Captured with the Phoenix ICON (100° field of view); wide-field contact fundus photograph of an infant: 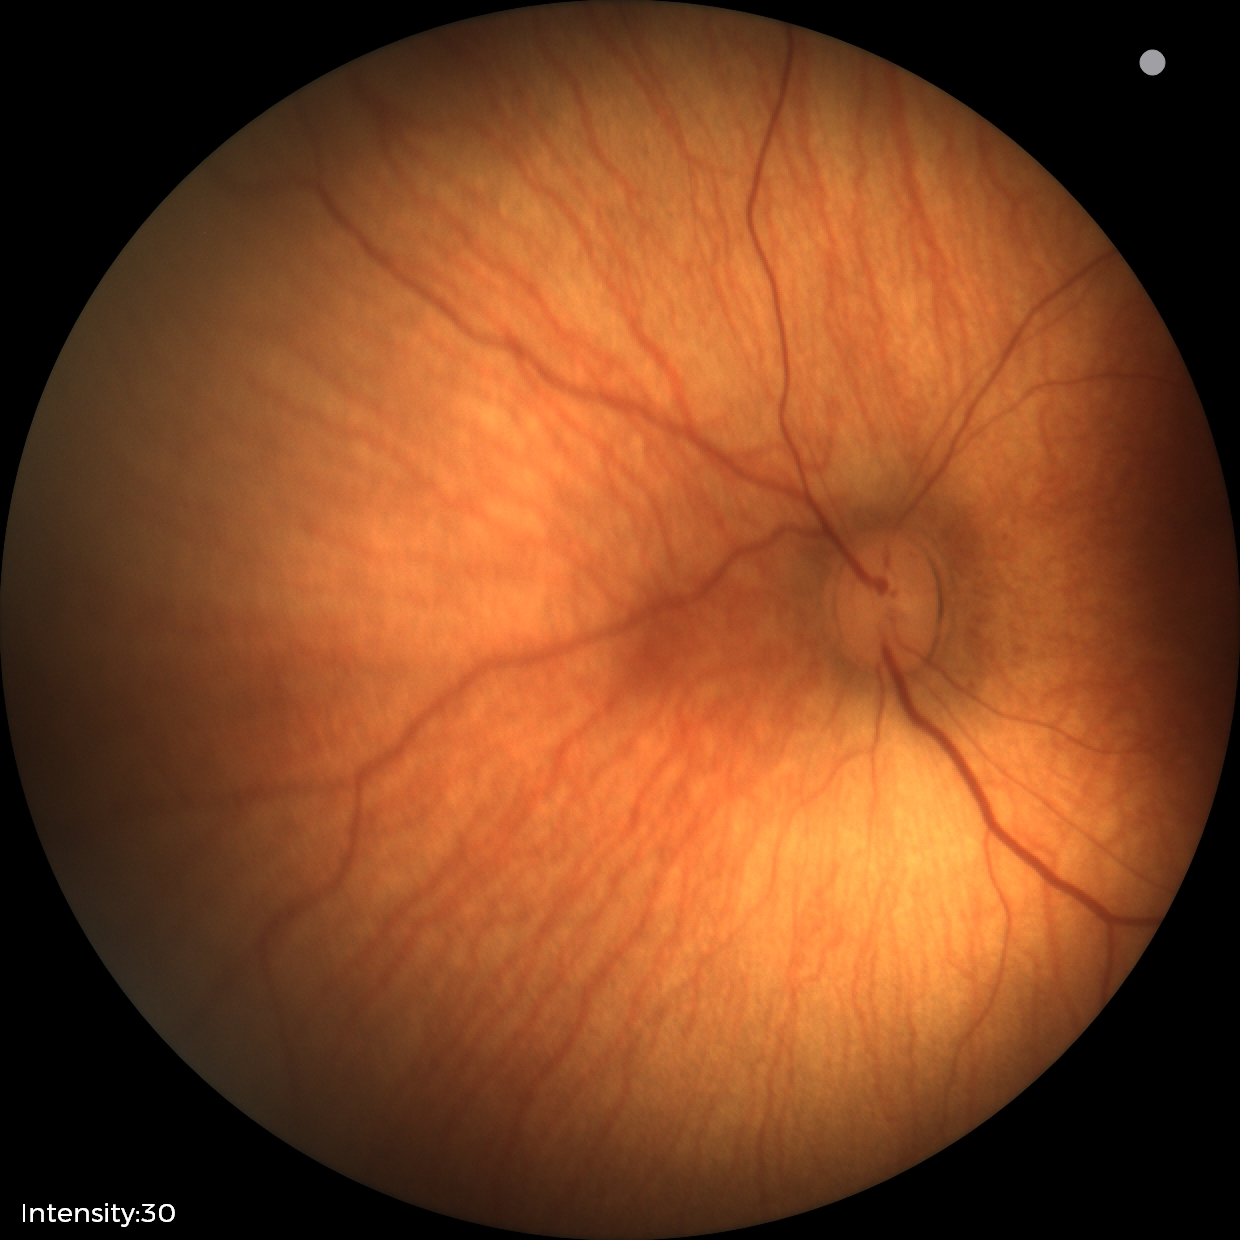

Examination with physiological retinal findings.